Posterior pole view, mydriatic (tropicamide and phenylephrine), 2228x1652.
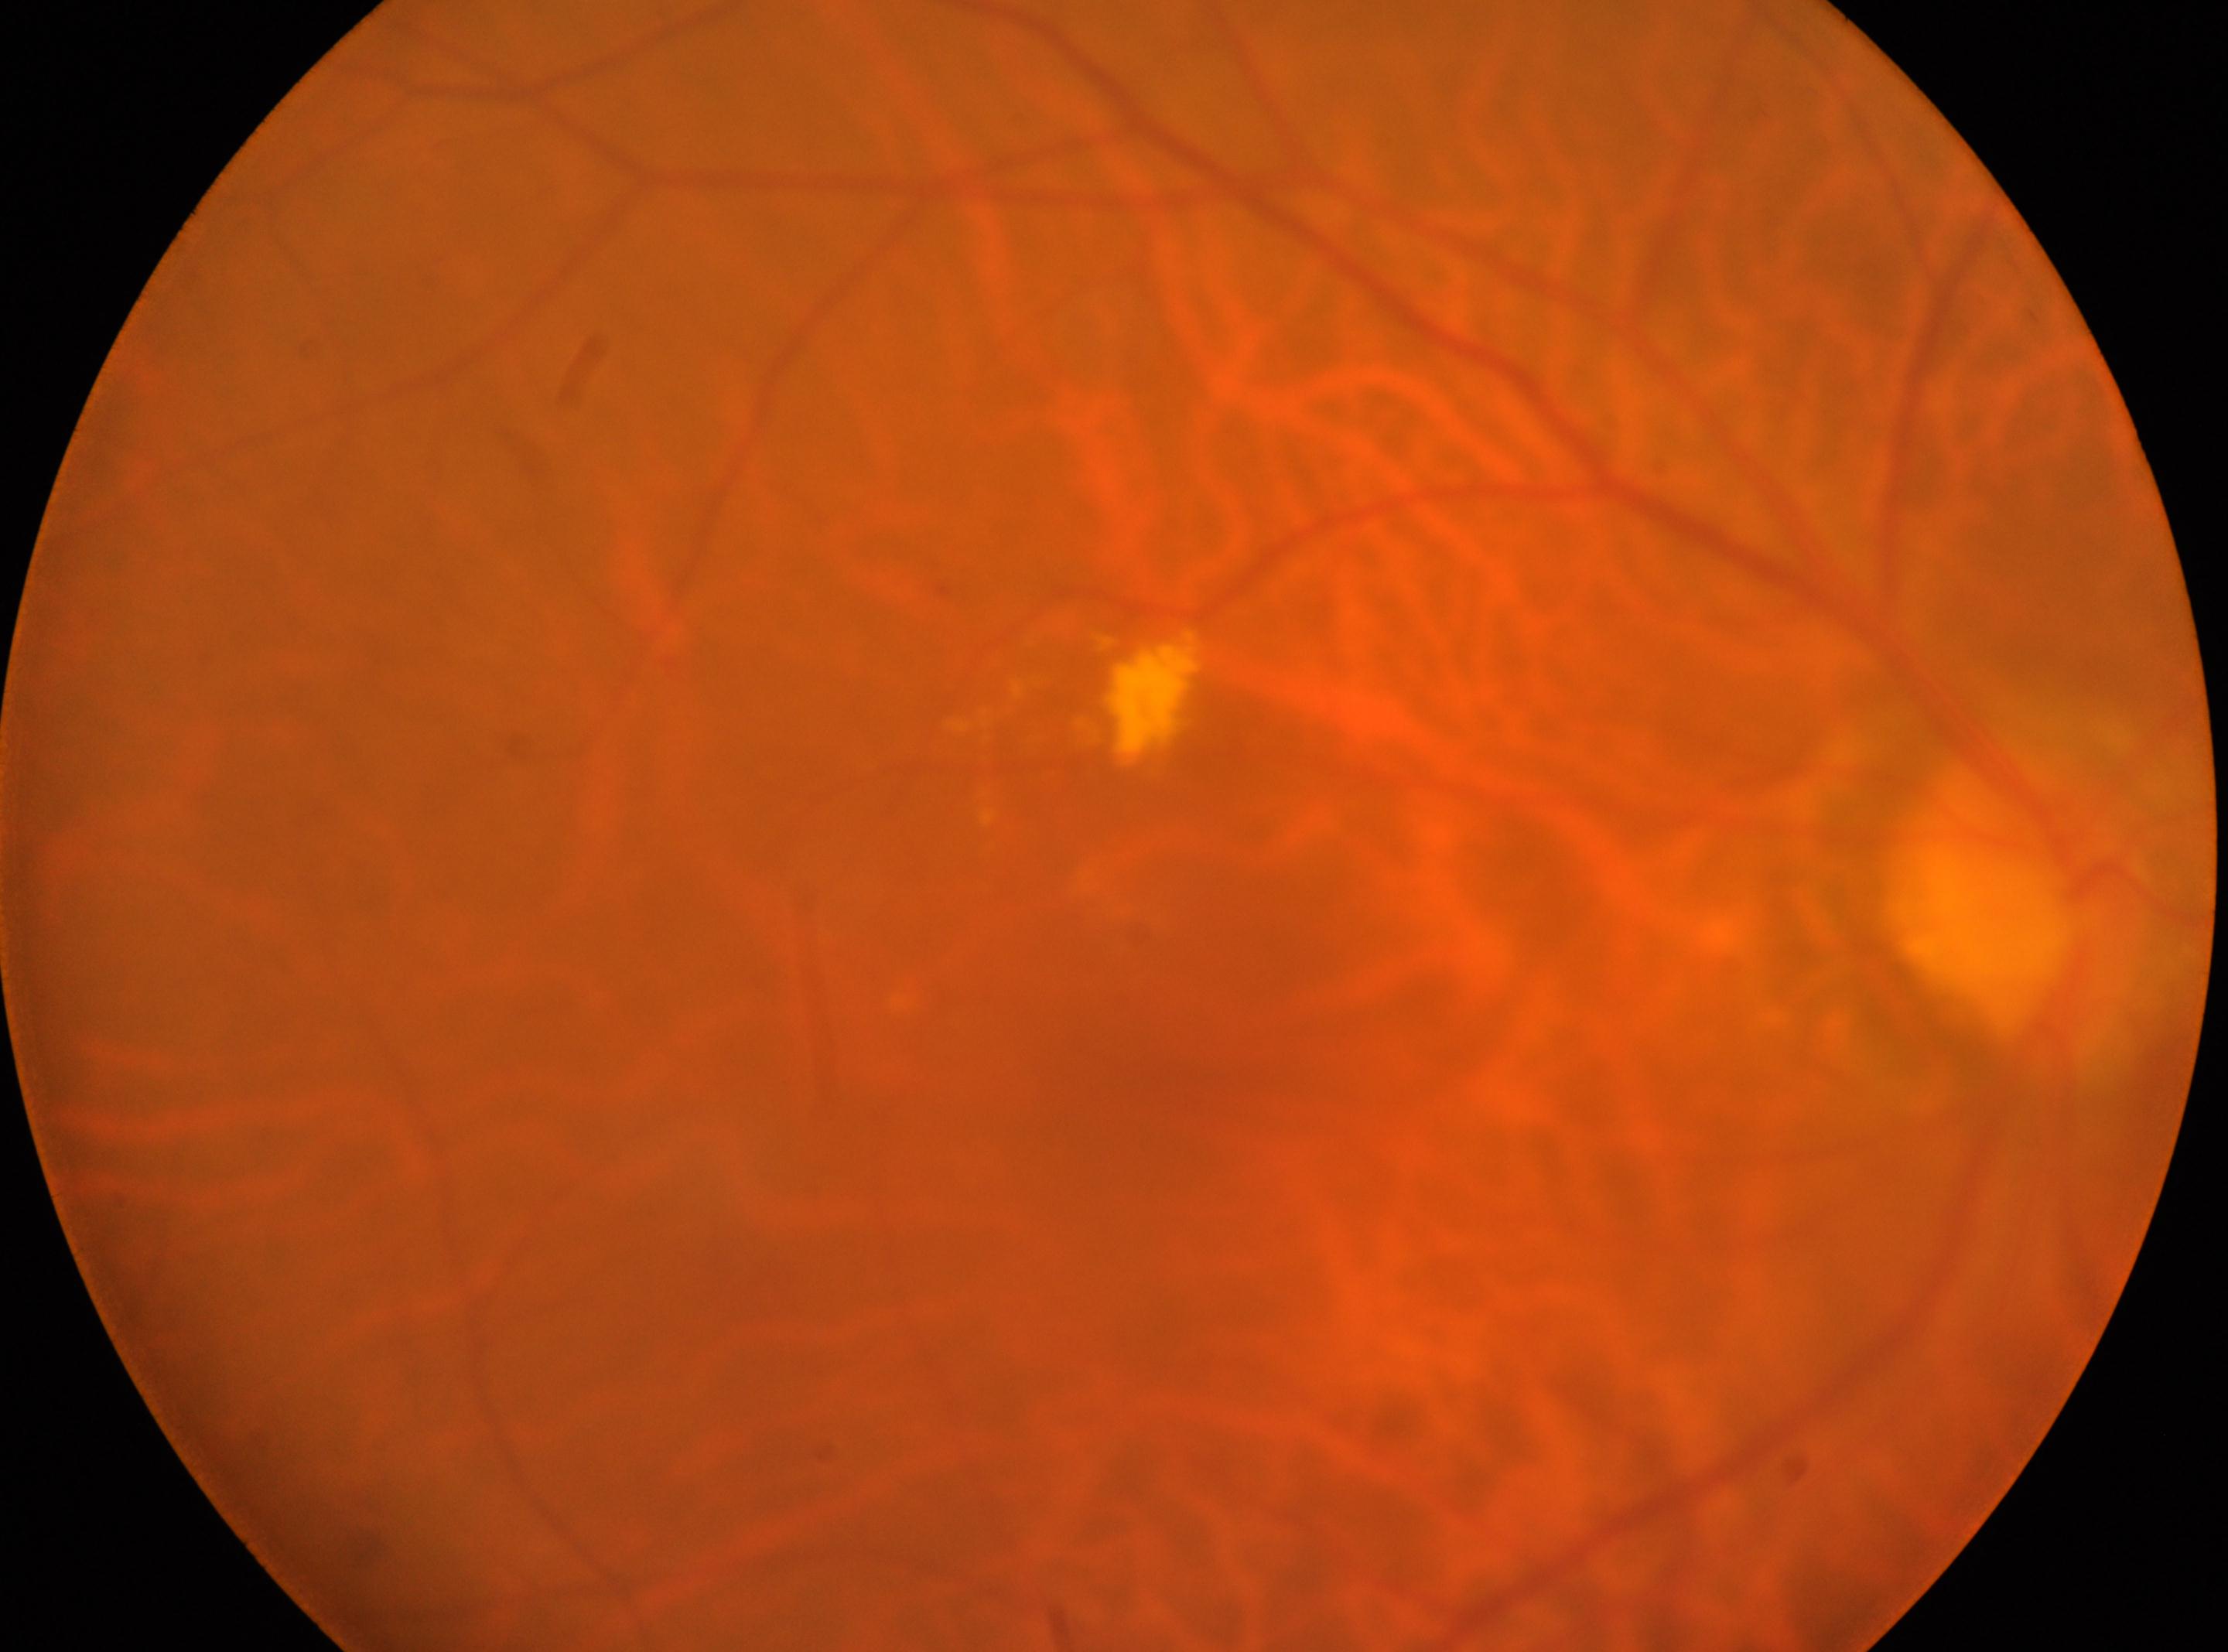

Fovea centralis located at 1139, 1060.
Diabetic retinopathy grade: moderate NPDR (2) — more than just microaneurysms but less than severe NPDR.
Optic nerve head: 2016, 911.
Imaged eye: right eye.